Image size 2352x1568 · fundus photo: 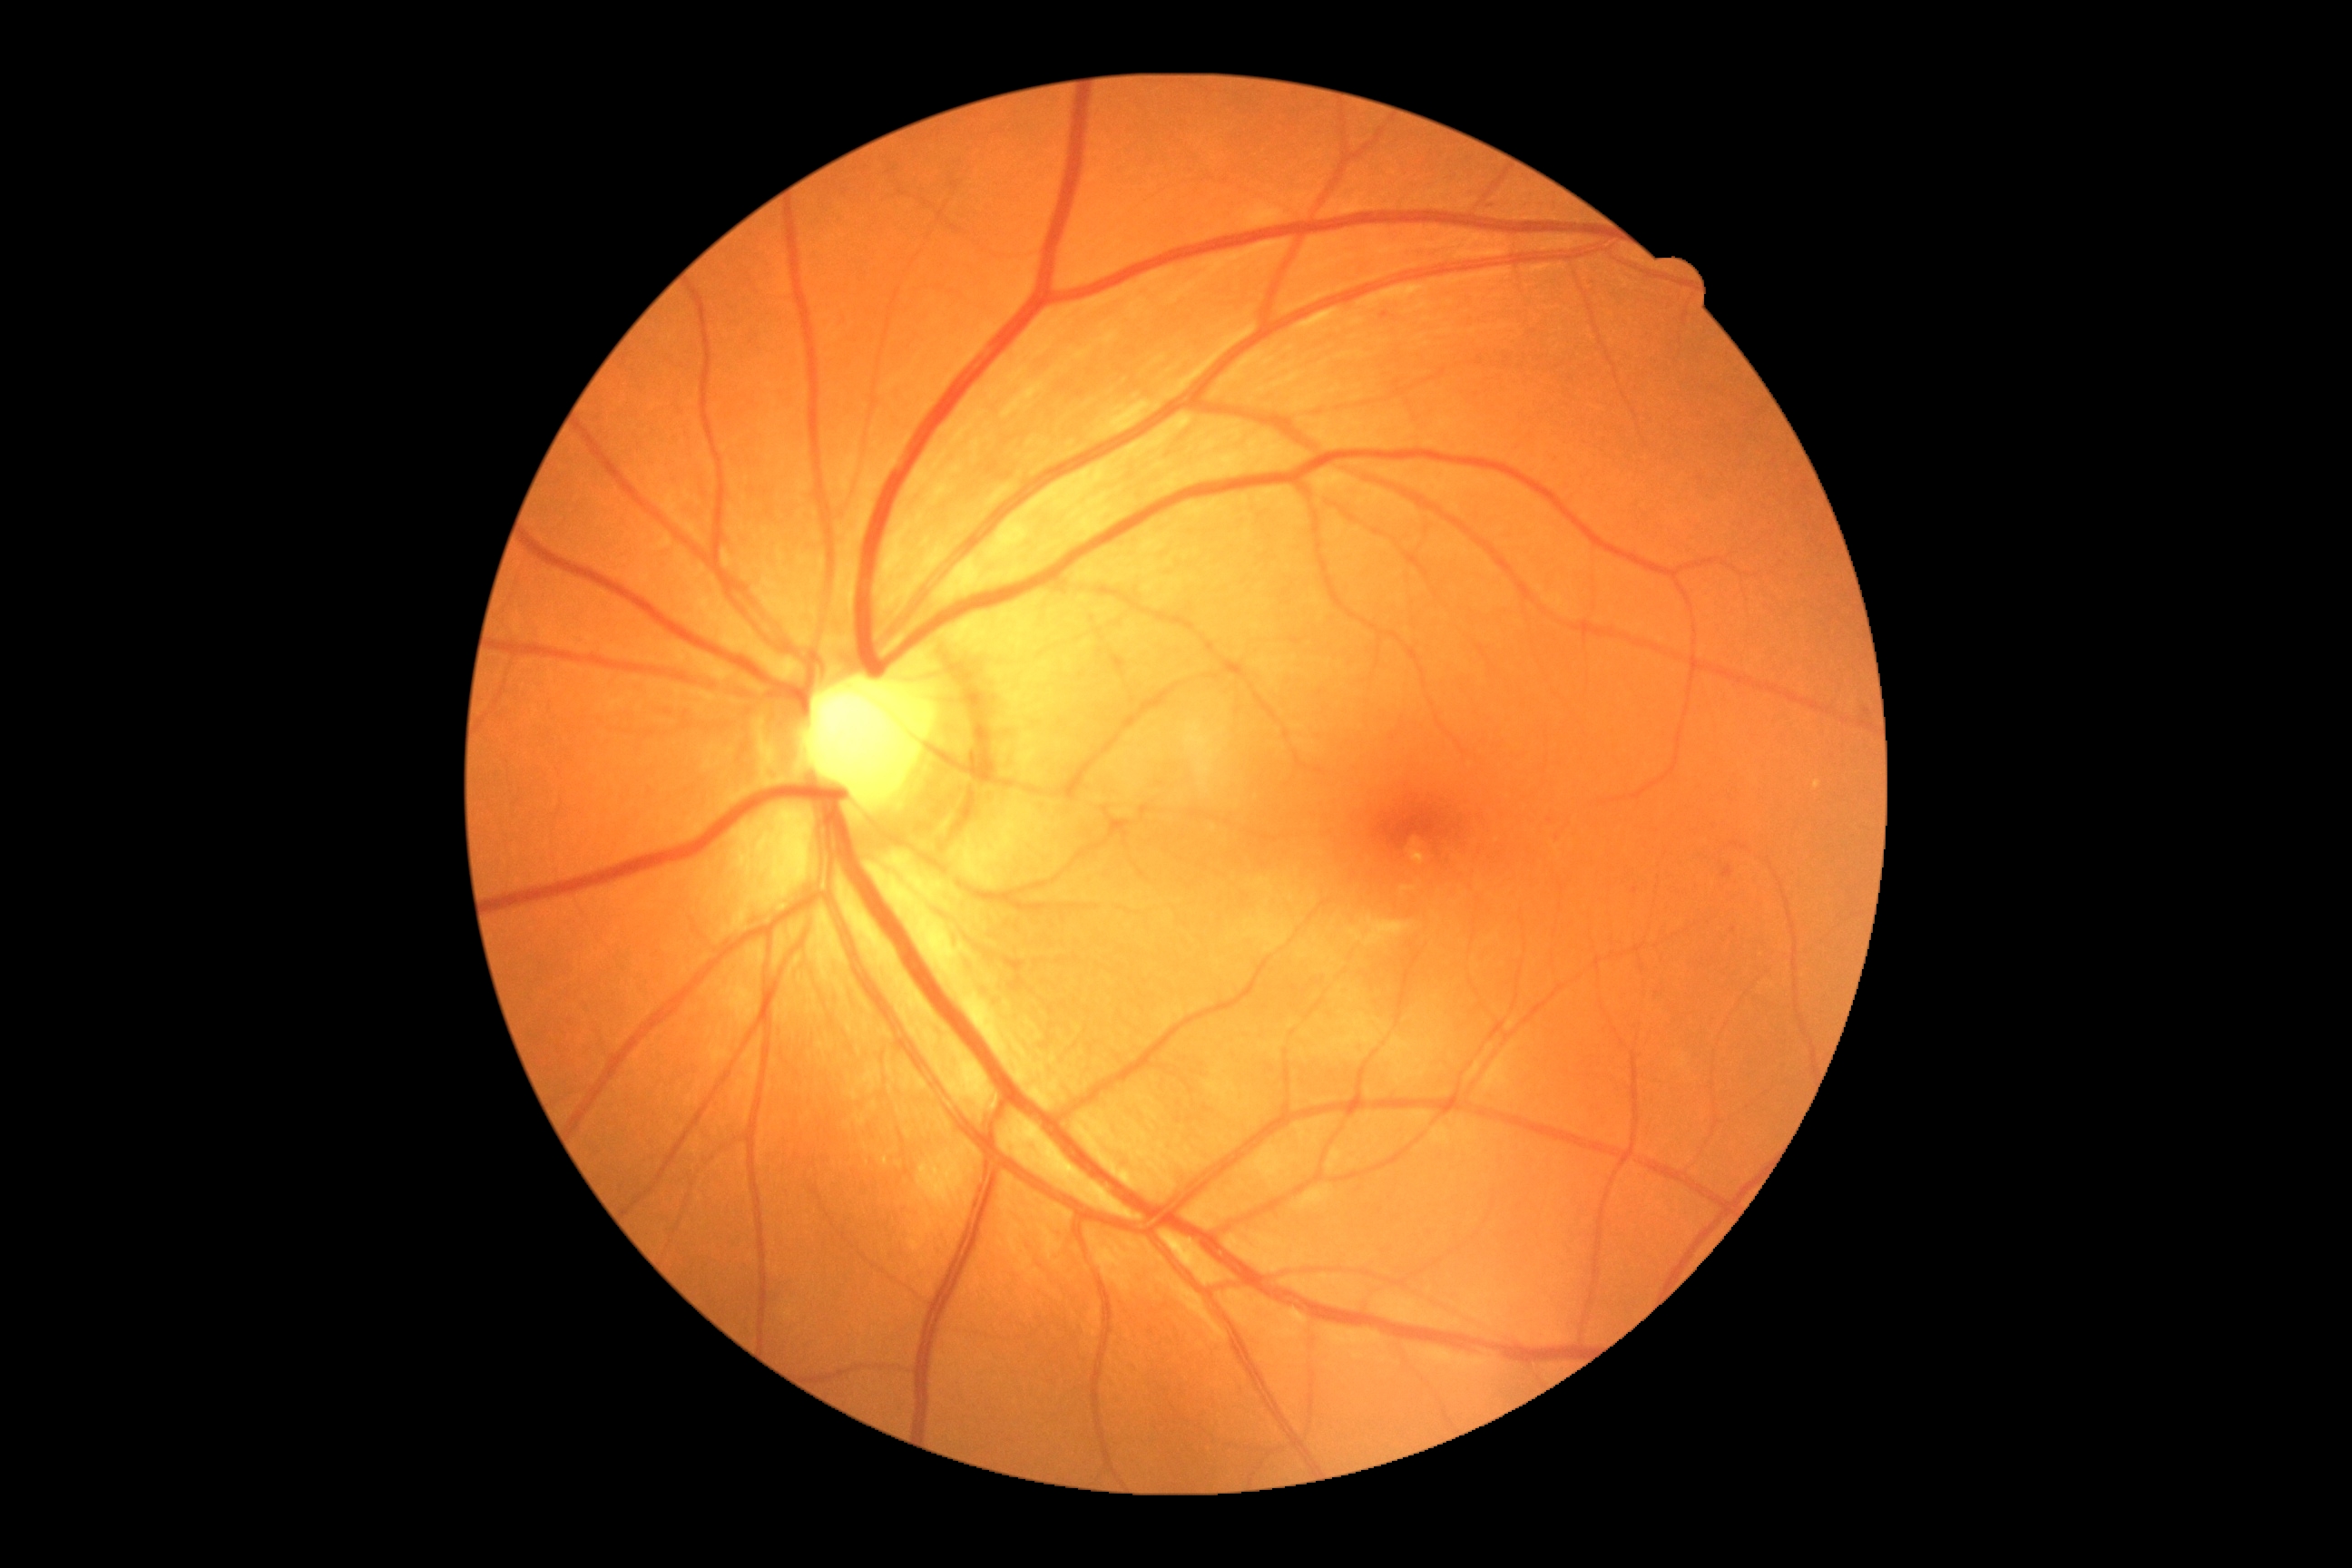 Retinopathy is 2.
Disease class: non-proliferative diabetic retinopathy.